Captured on a Nidek AFC-330 fundus camera
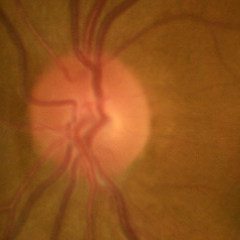

No glaucoma.